Diabetic retinopathy graded by the modified Davis classification · 848 by 848 pixels.
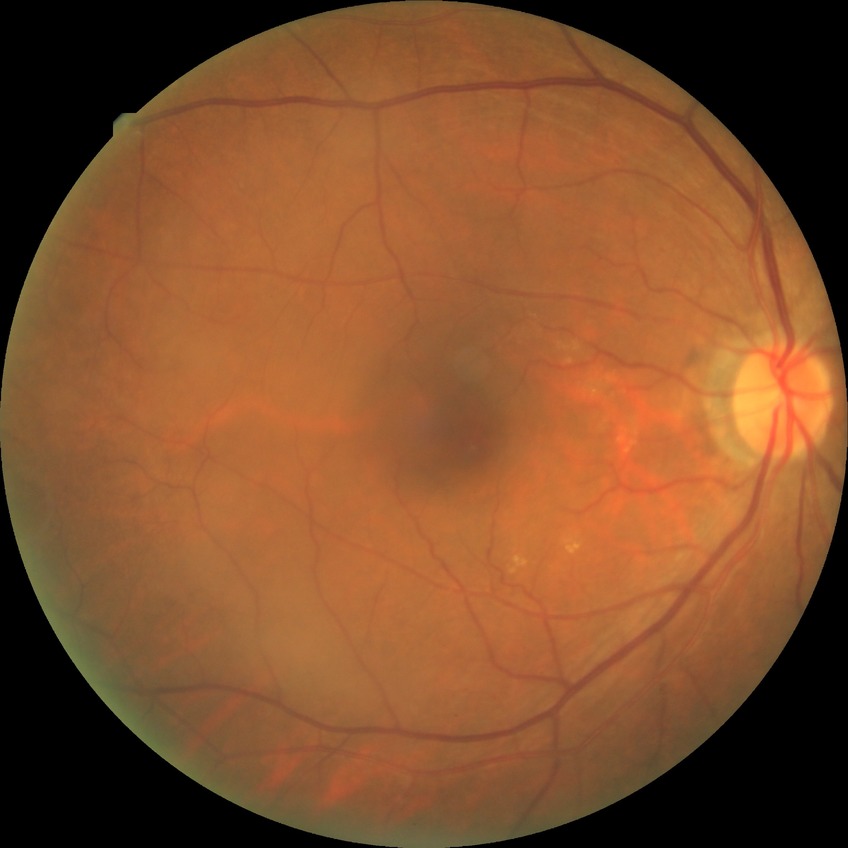
Davis grading: no diabetic retinopathy.